45° FOV; retinal fundus photograph; 2352x1568px
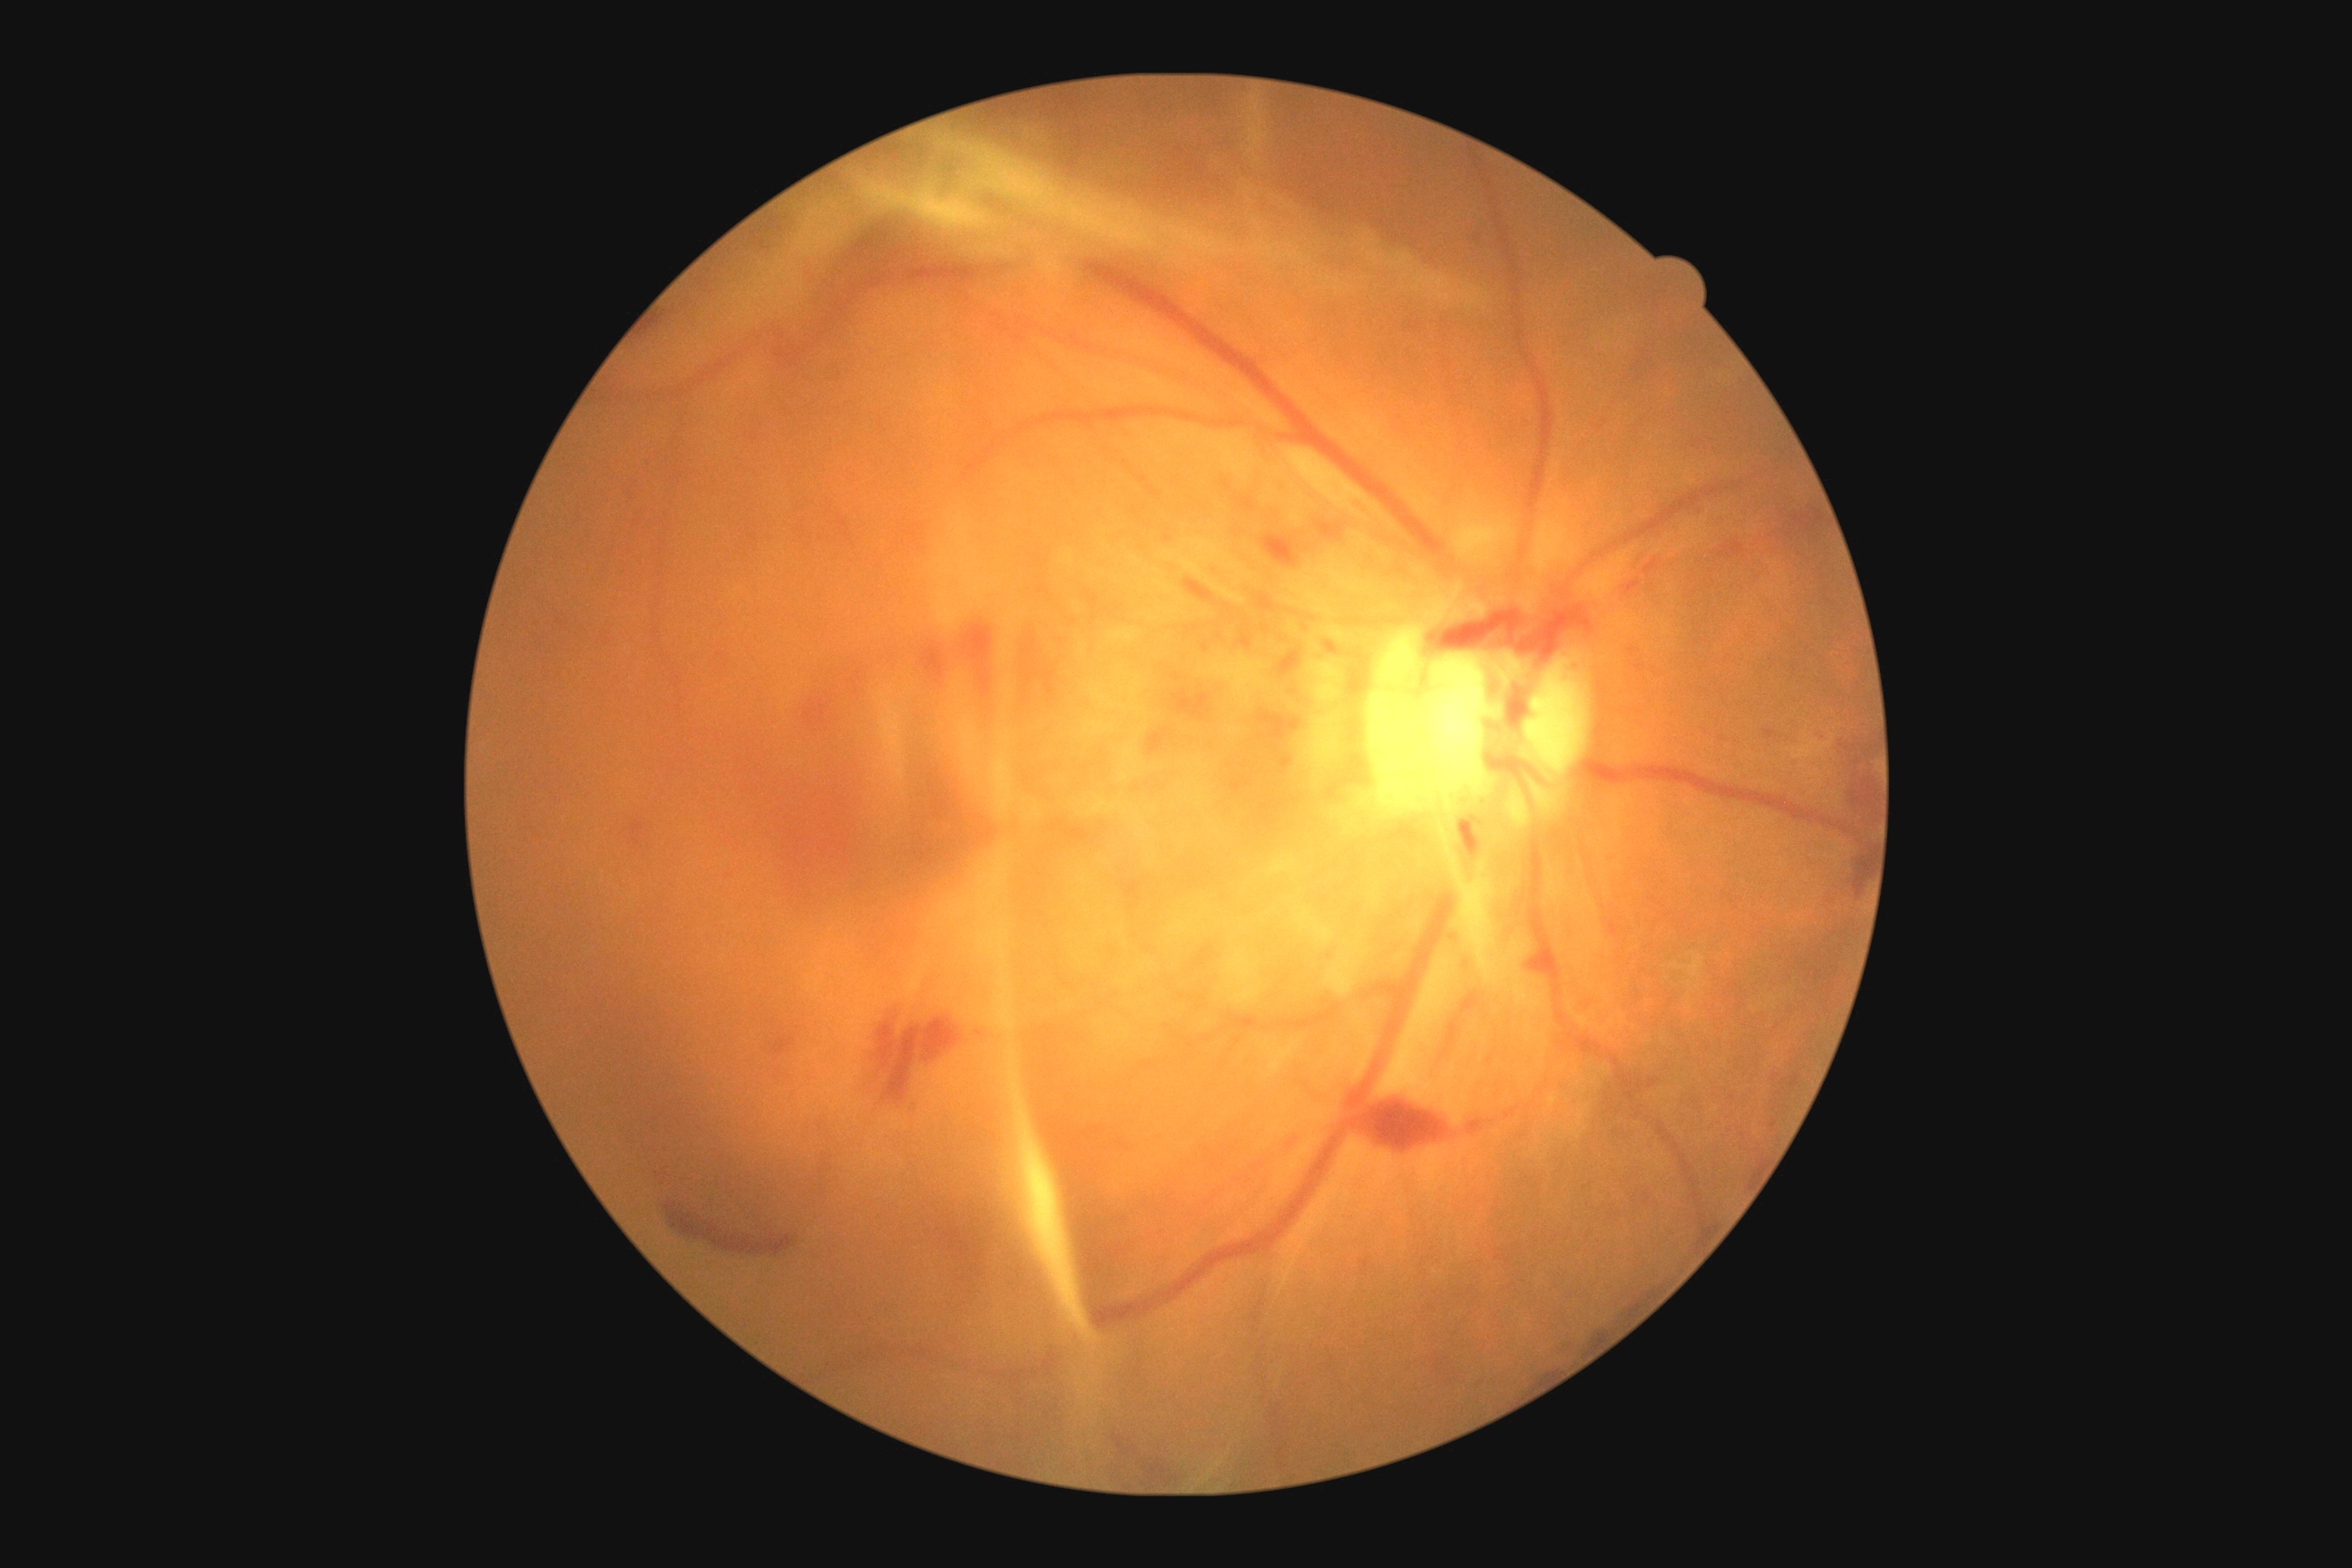
DR = 4.